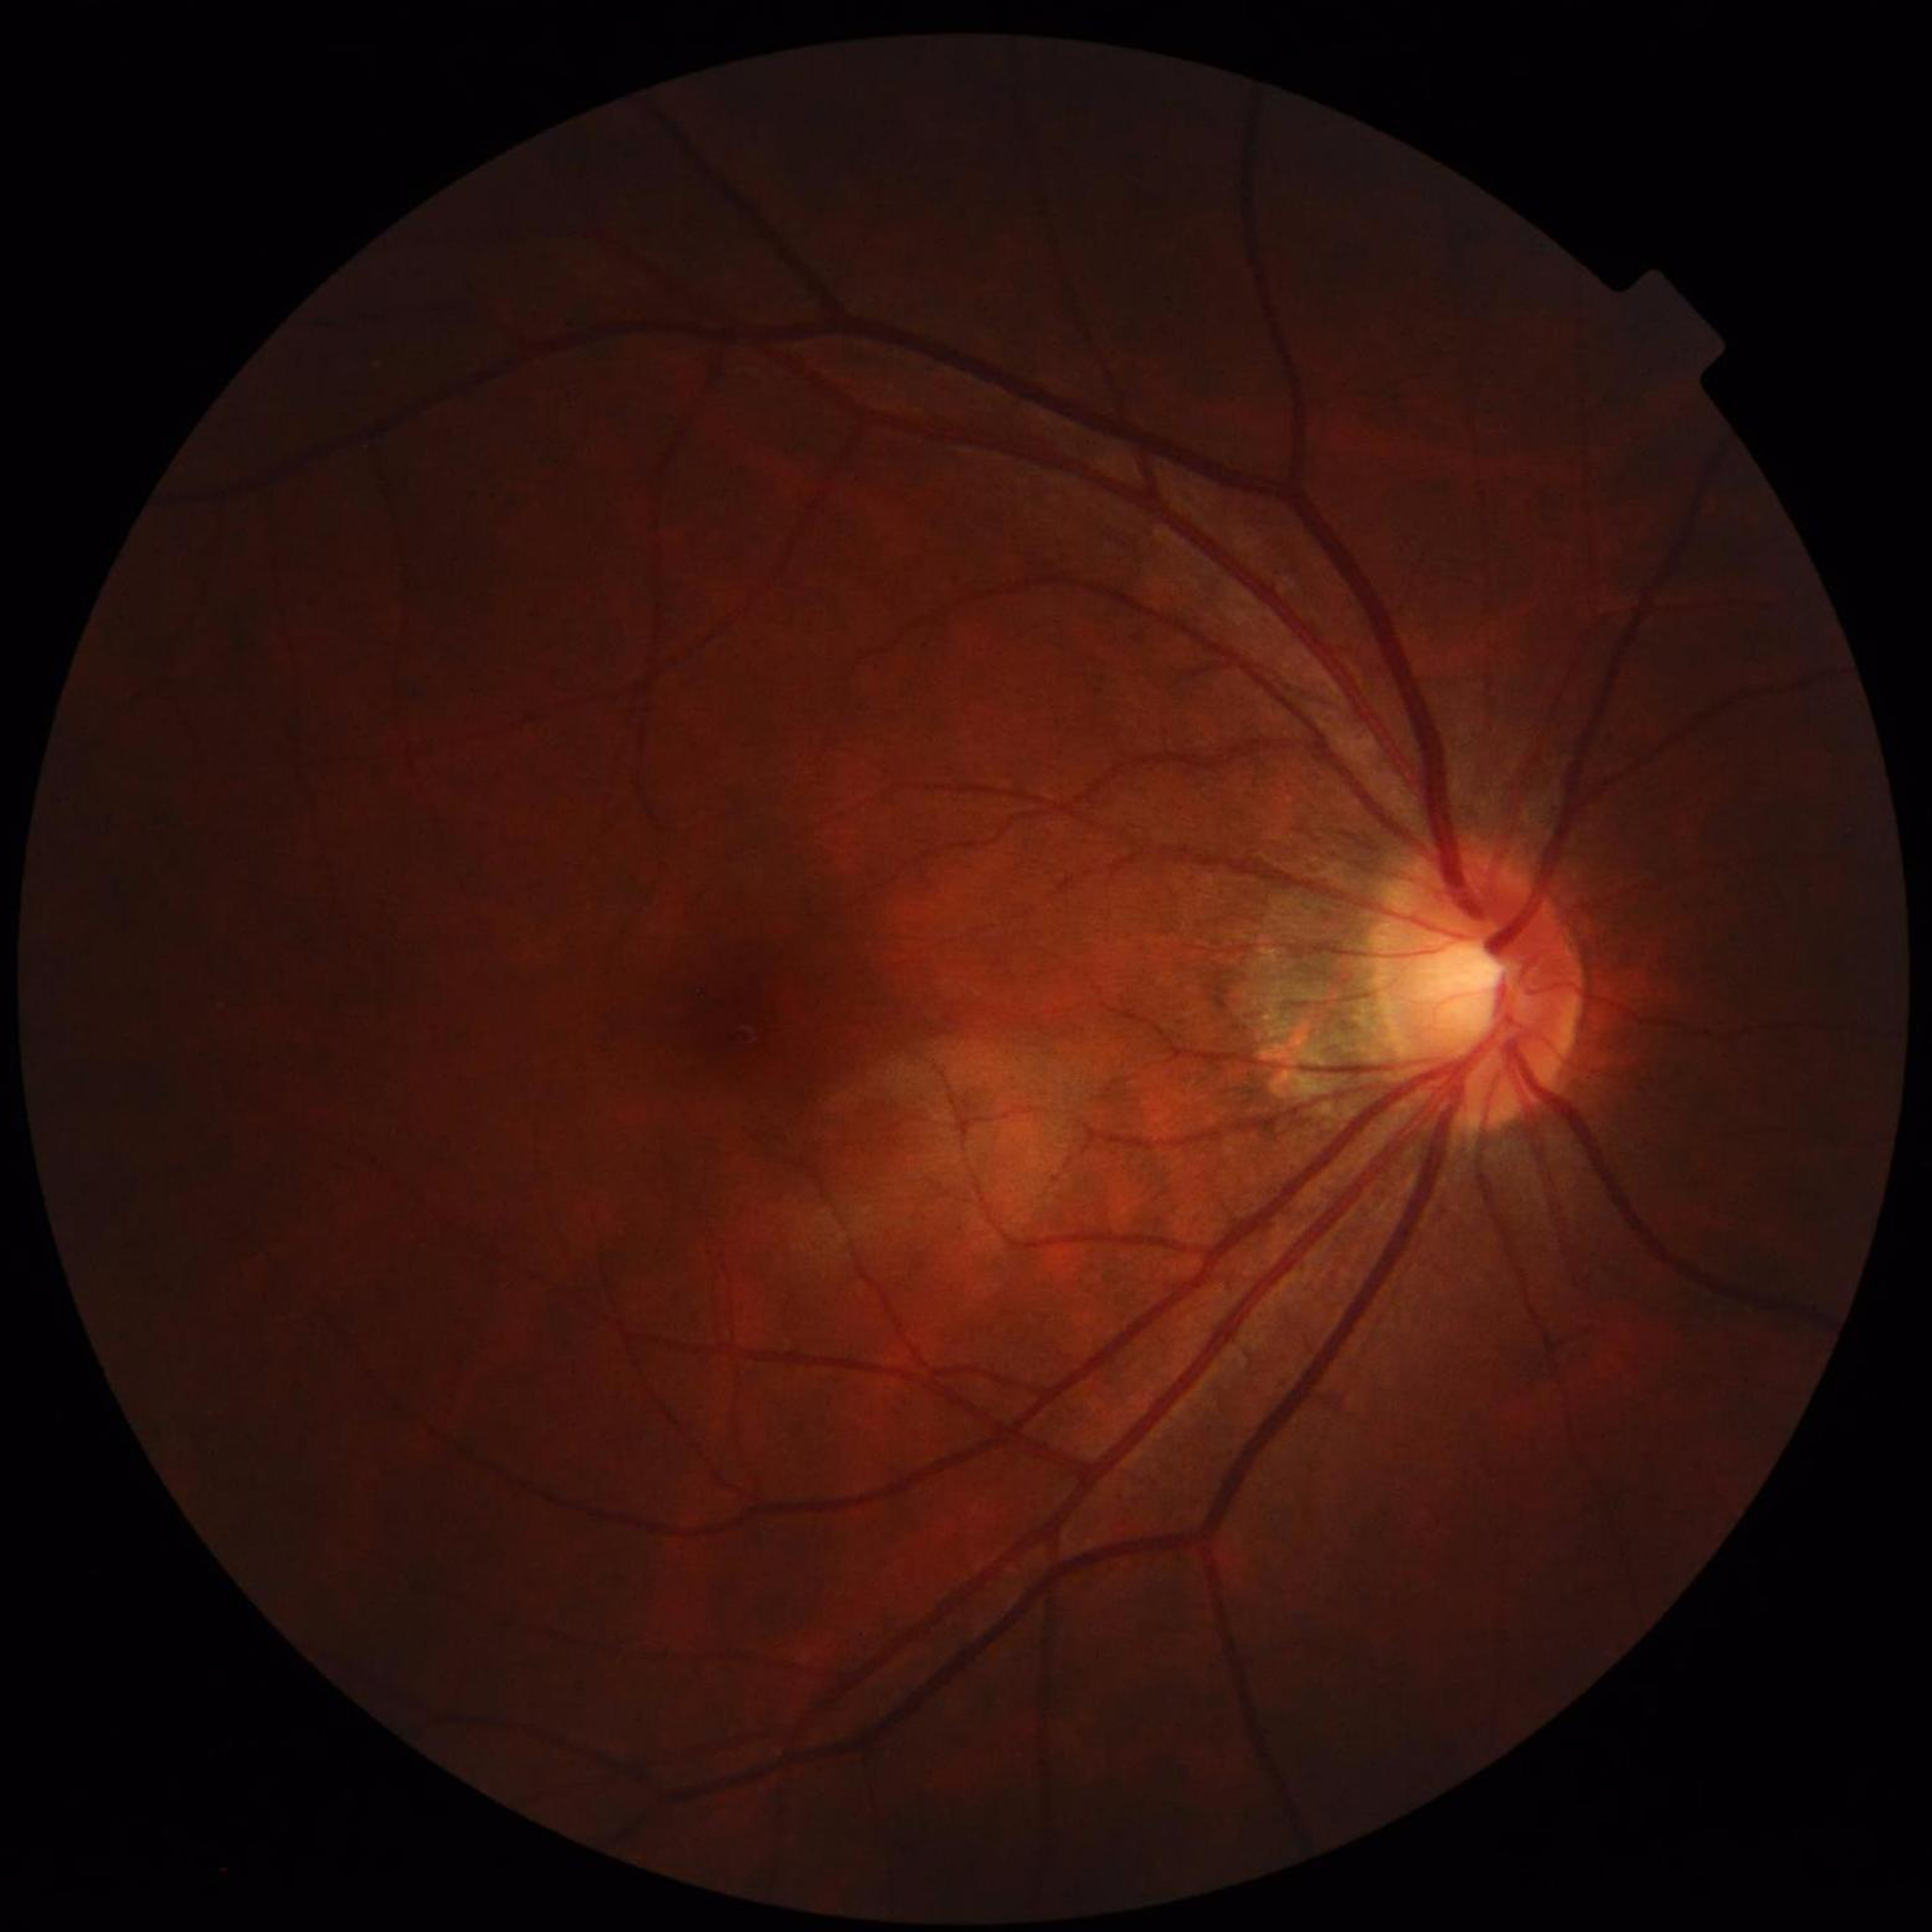 Eye affected by glaucoma. Photo quality: contrast adequate, illumination/color distortion present, no blur.